DR severity per modified Davis staging.
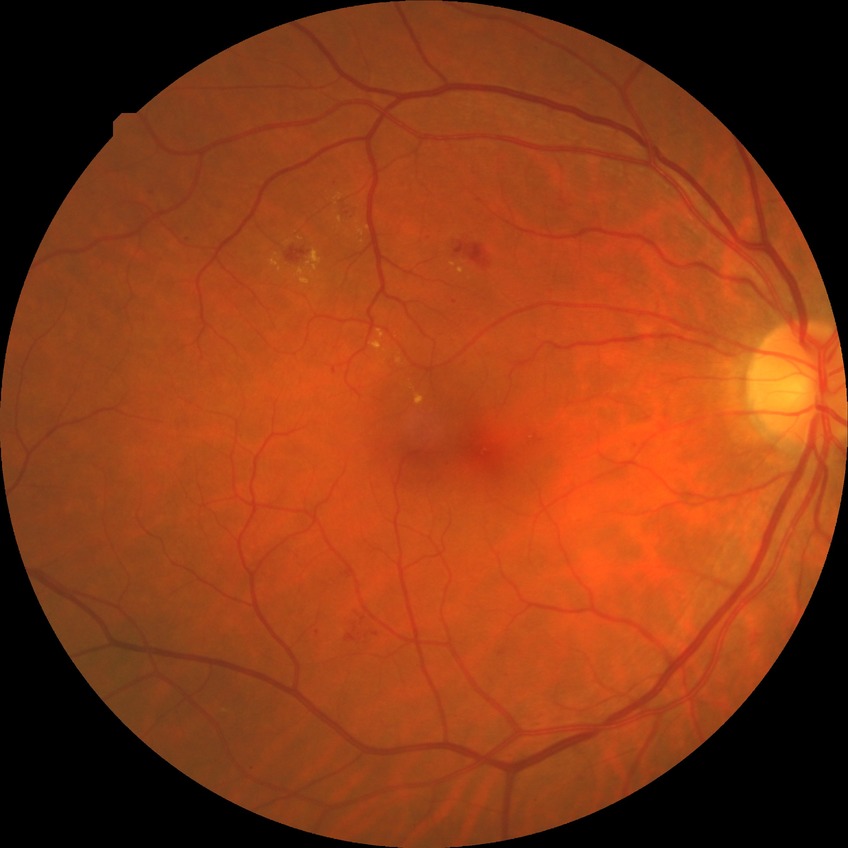 Diabetic retinopathy grade is simple diabetic retinopathy.